Camera: Natus RetCam Envision (130° FOV); wide-field fundus photograph from neonatal ROP screening
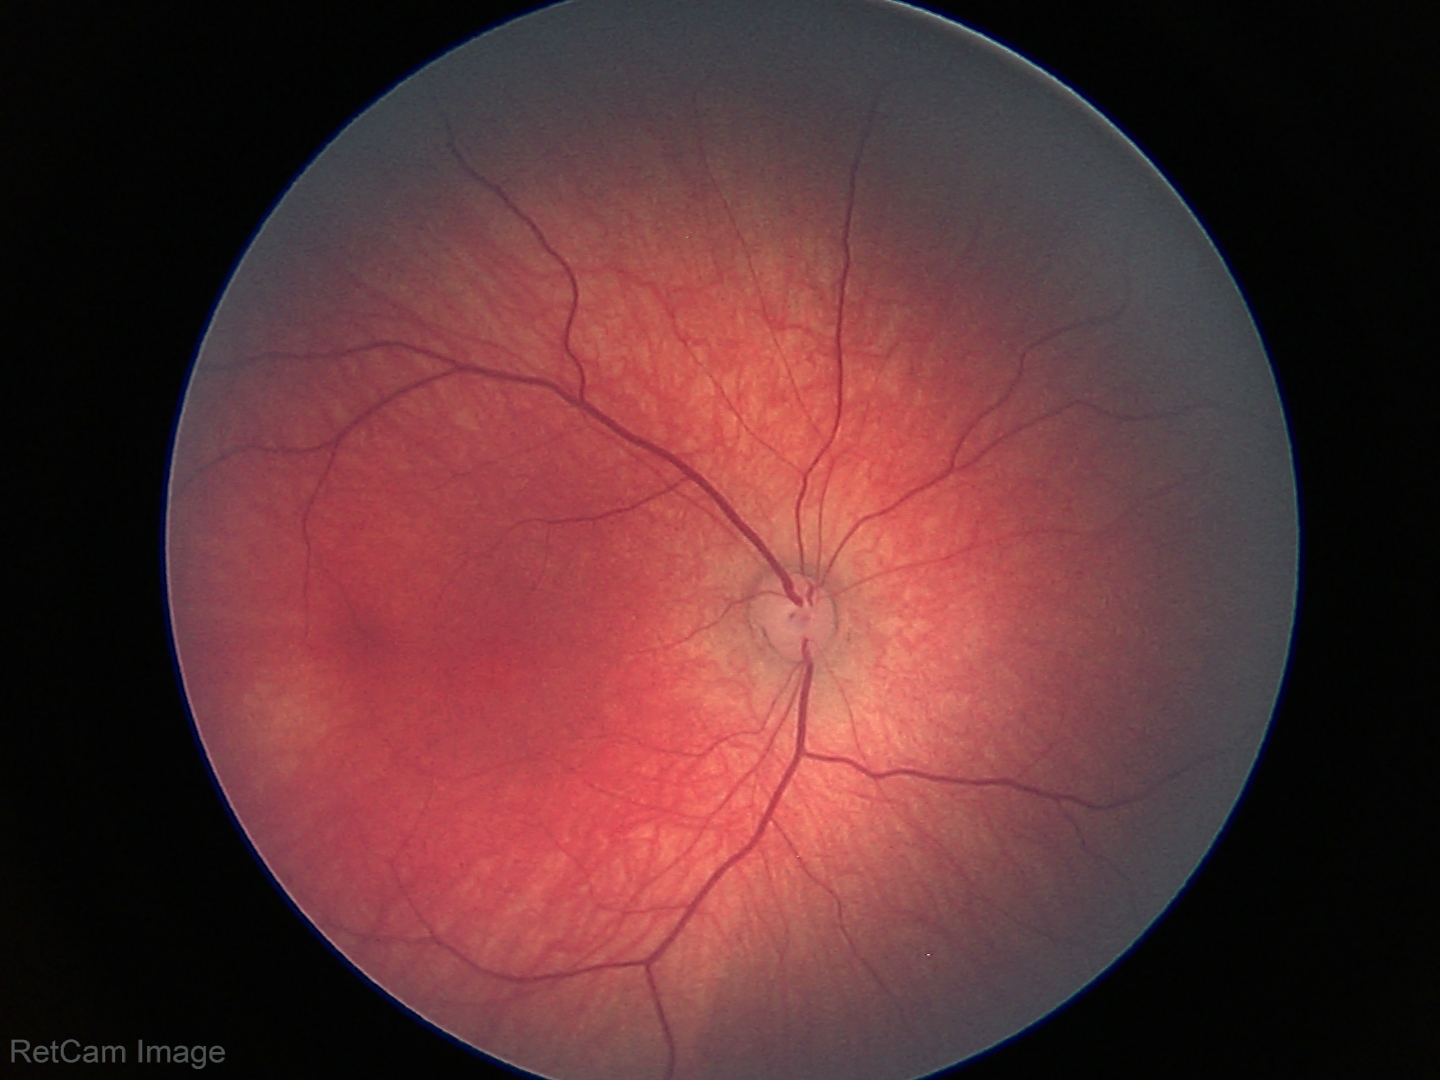
Screening examination with no abnormal retinal findings.